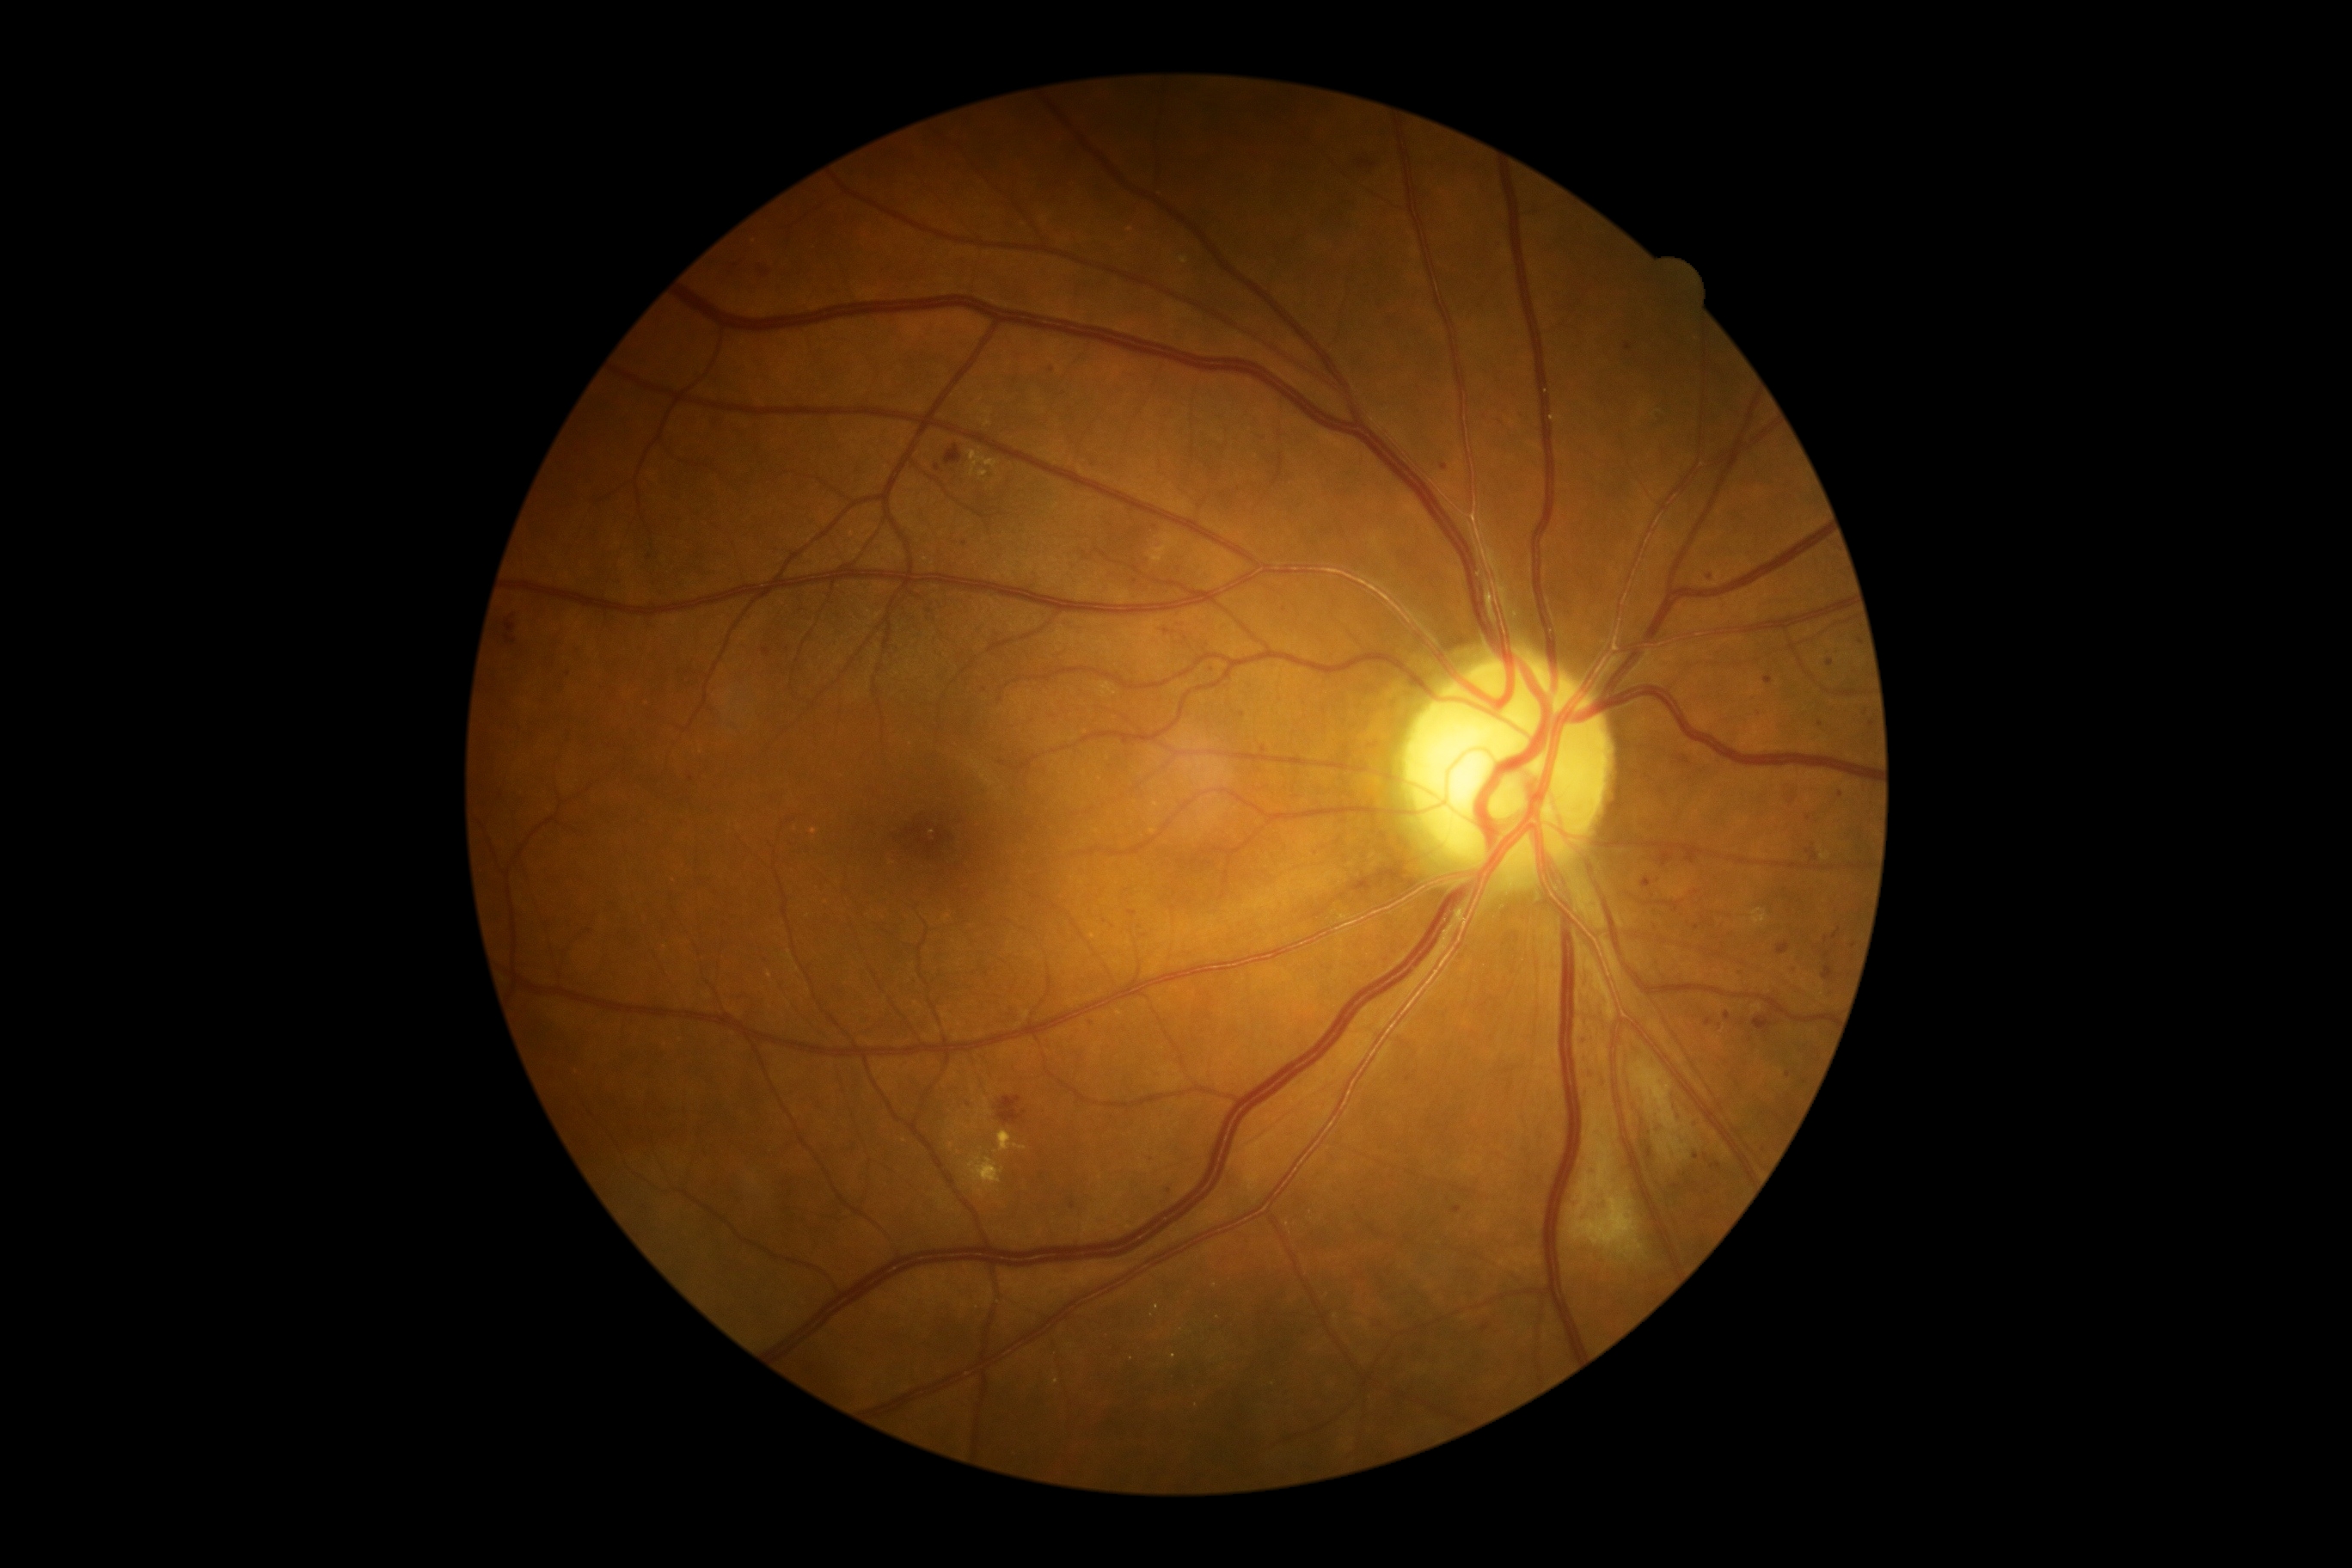

Retinopathy: grade 2
Selected lesions:
microaneurysms (subset) = rect(1712, 1163, 1720, 1168); rect(1094, 1019, 1101, 1031); rect(1806, 848, 1820, 862); rect(1084, 553, 1089, 561); rect(1572, 1201, 1581, 1210); rect(1853, 775, 1865, 780); rect(506, 635, 517, 644)
Small microaneurysms approximately at <point>1827, 955</point>; <point>1132, 913</point>; <point>788, 649</point>; <point>1806, 1082</point>; <point>764, 964</point>; <point>1312, 855</point>; <point>1157, 527</point>; <point>1697, 927</point>; <point>1264, 748</point>; <point>1788, 1074</point>; <point>1826, 940</point>